Retinal fundus photograph. 45° FOV.
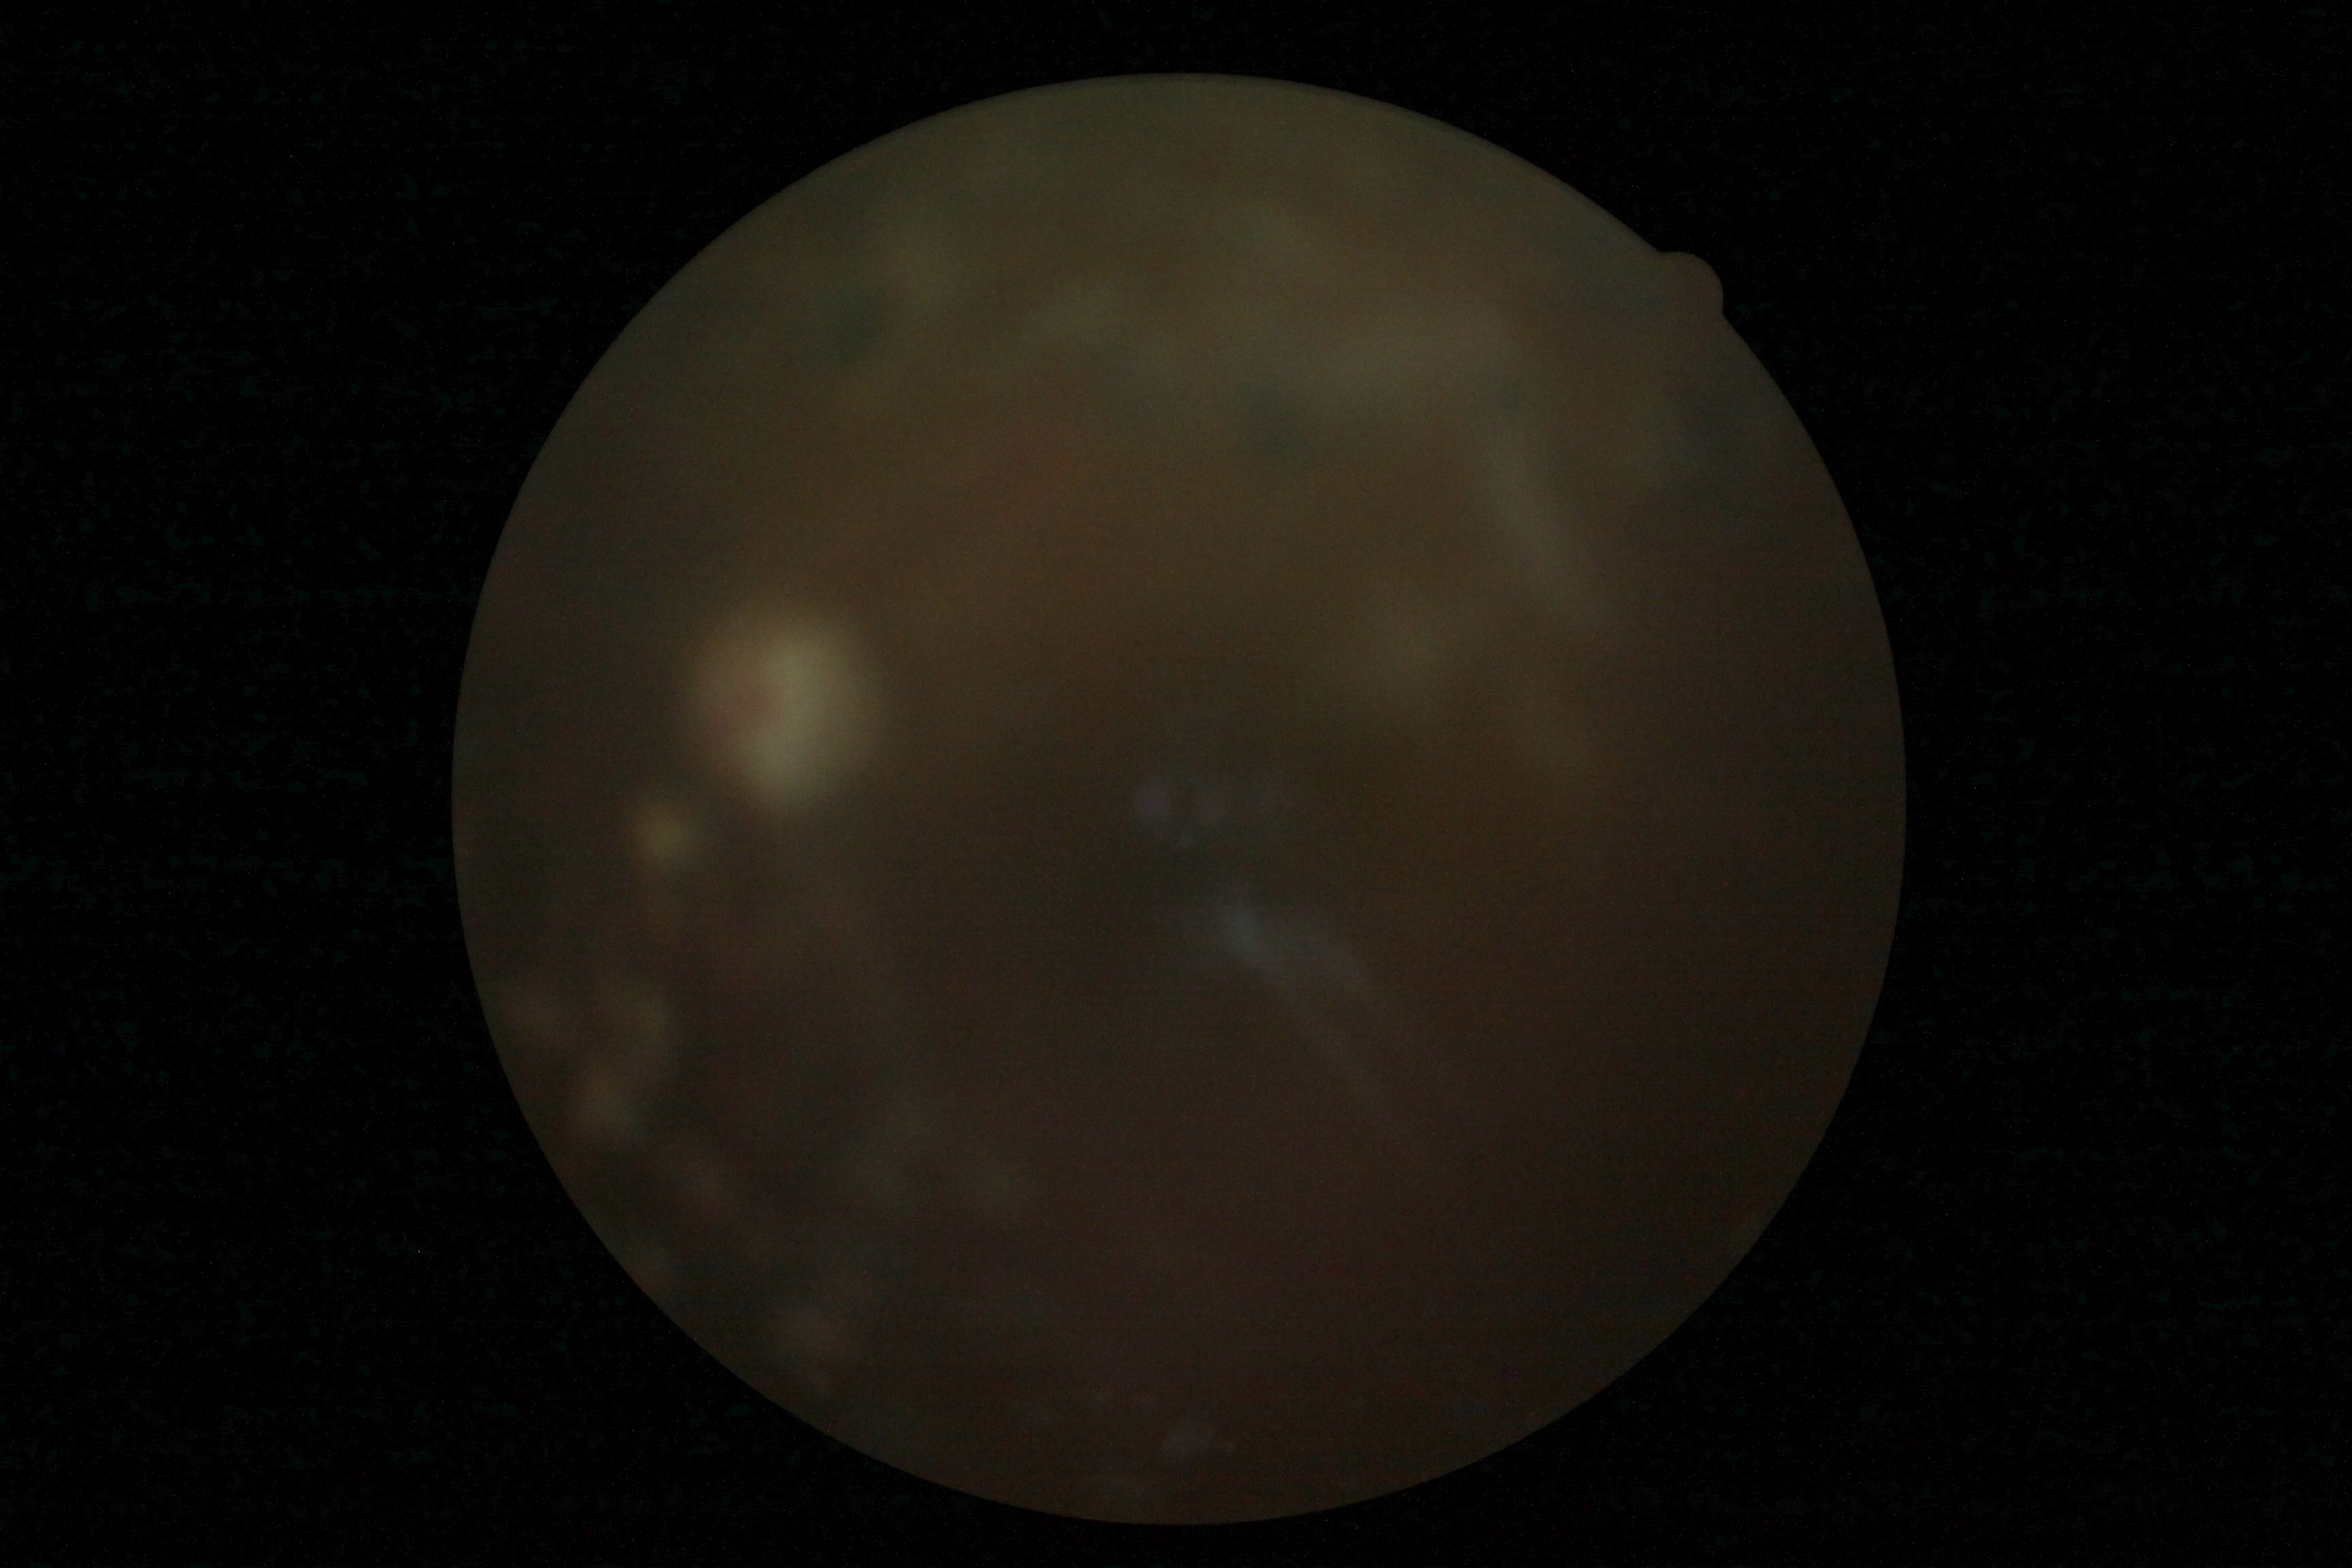 DR stage@ungradable, image quality@insufficient for DR assessment.